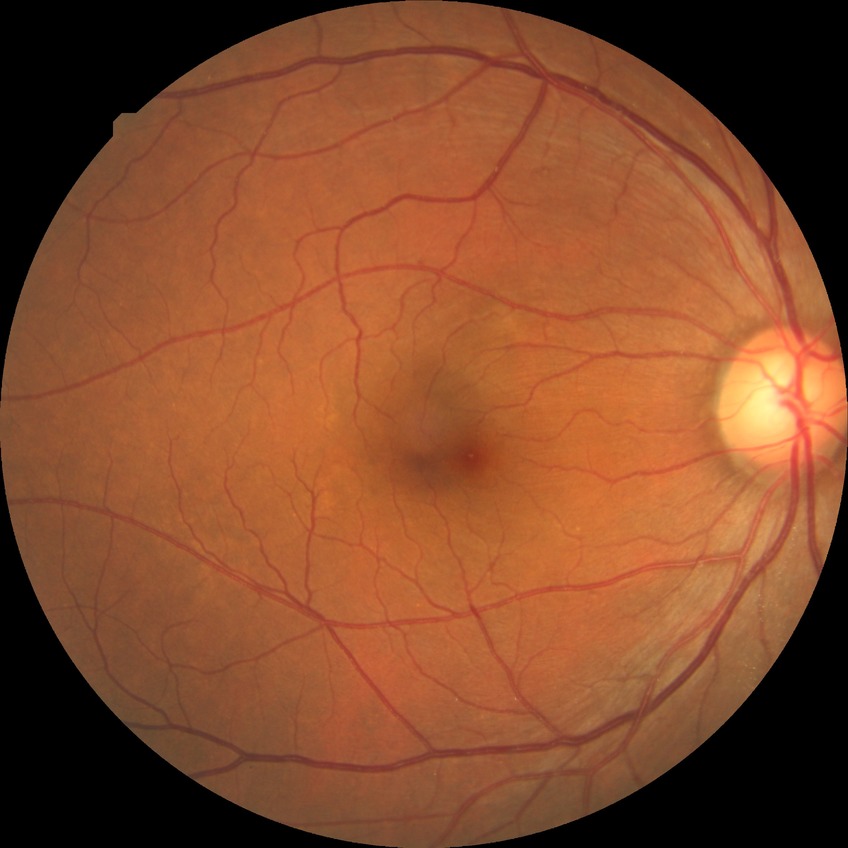

No apparent diabetic retinopathy.
Modified Davis grade is NDR.